848x848px
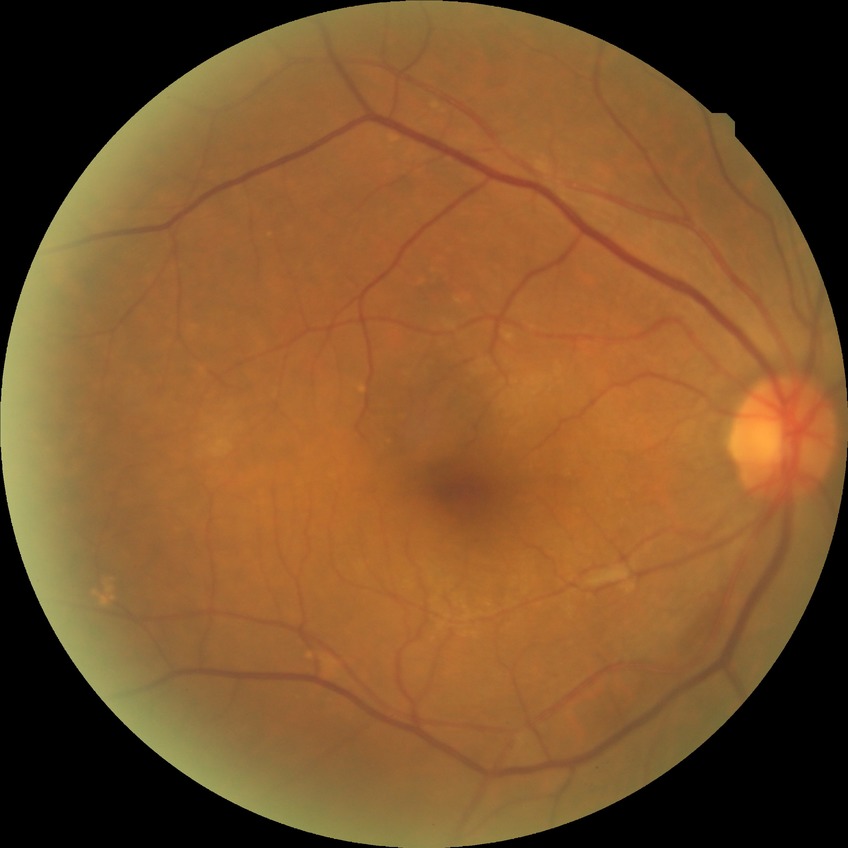
Diabetic retinopathy (DR): NDR (no diabetic retinopathy).